Davis DR grading · posterior pole color fundus photograph · nonmydriatic: 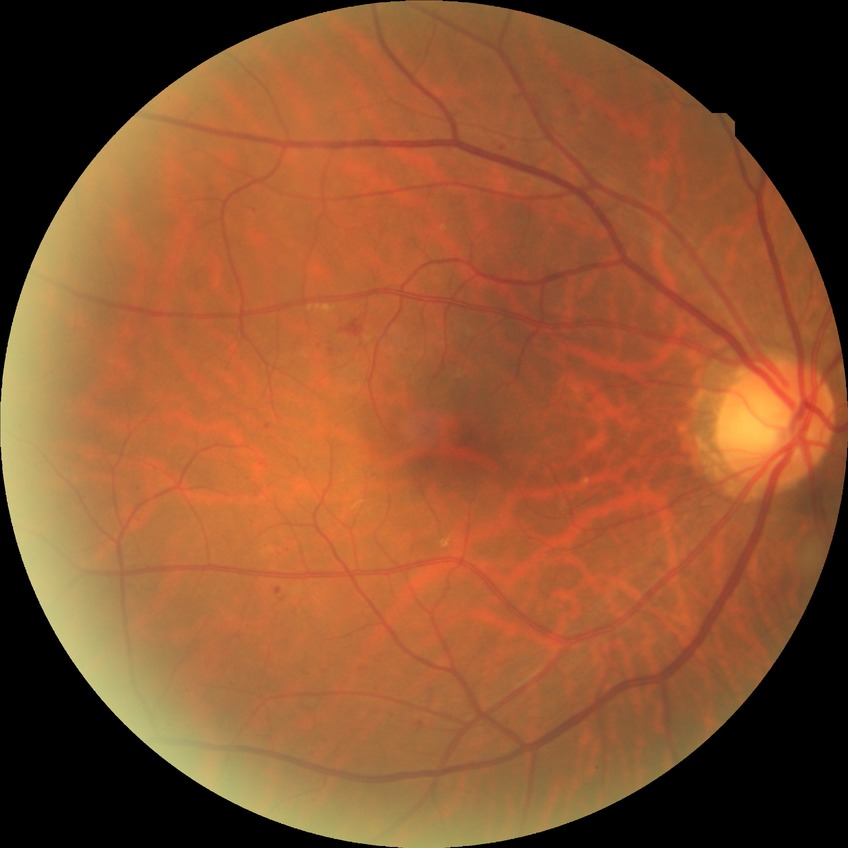

diabetic retinopathy stage = simple diabetic retinopathy.